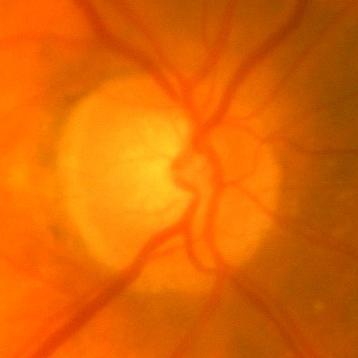 Q: Glaucoma assessment?
A: No glaucomatous damage.